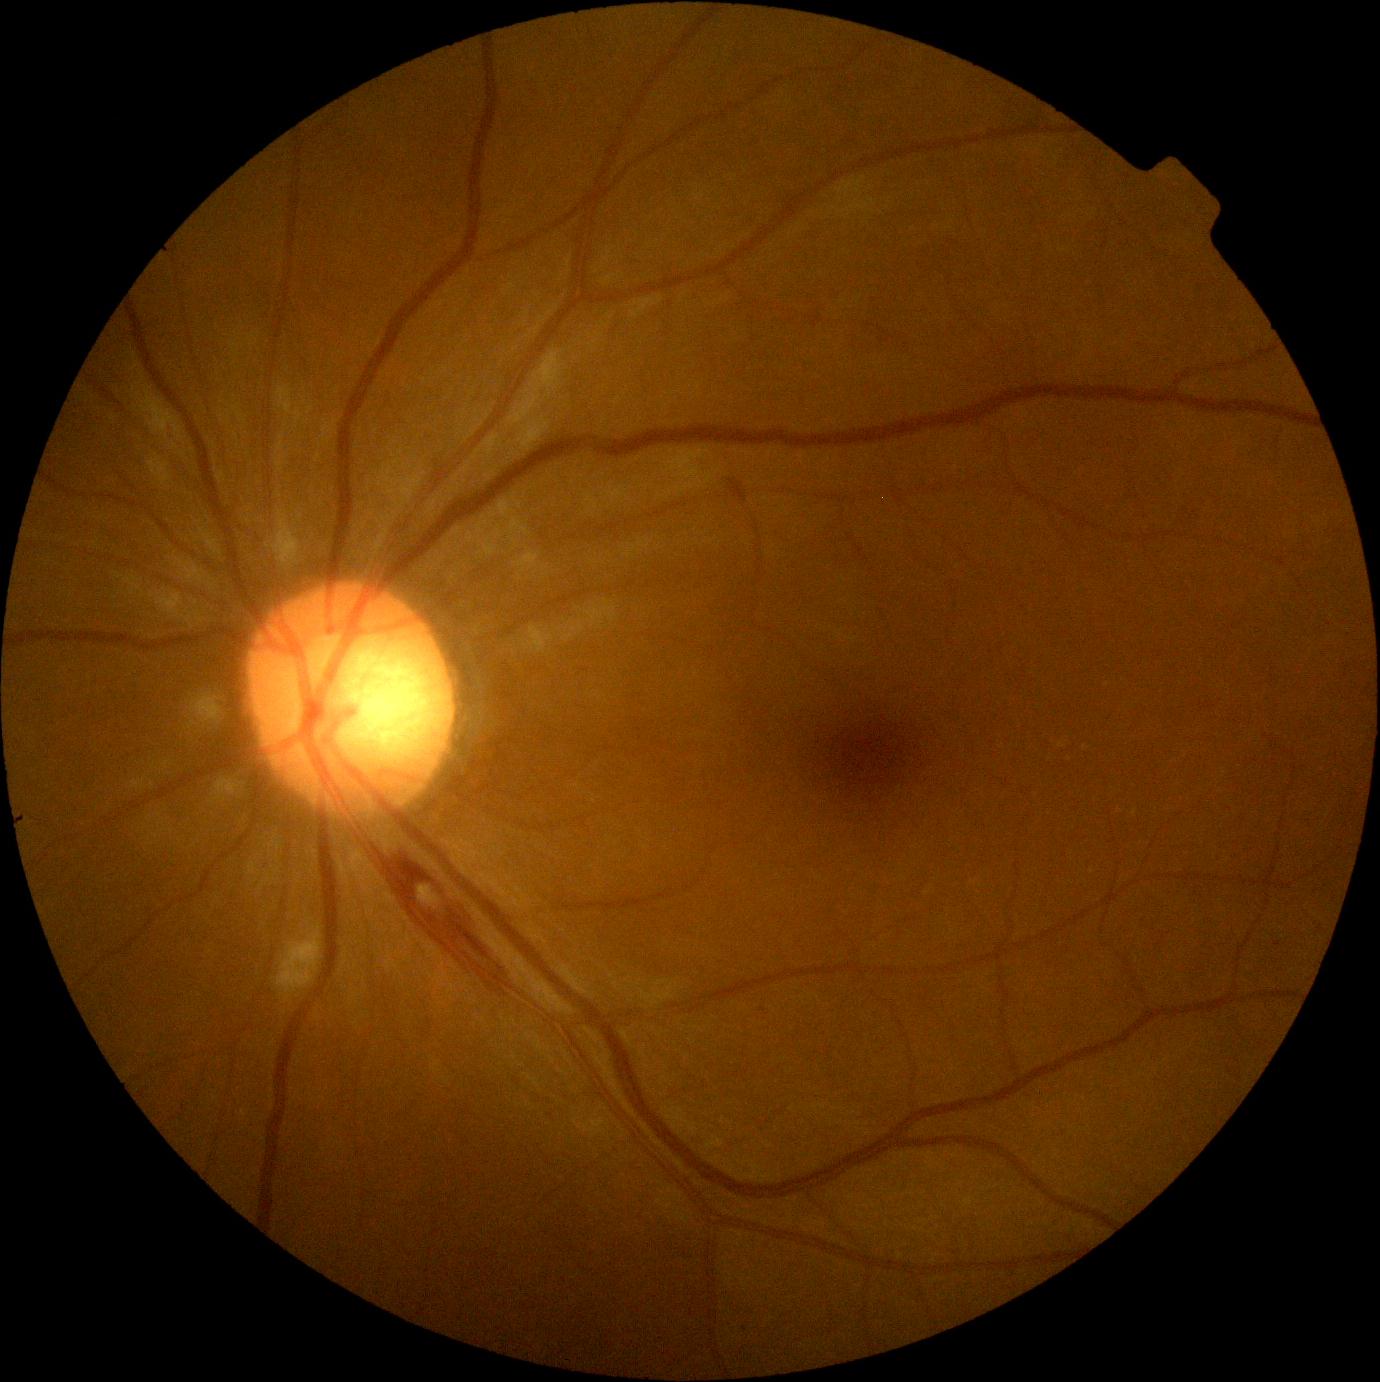
Diabetic retinopathy (DR) is grade 2.